Ultra-widefield fundus photograph · 1924x1556 · 200° field of view
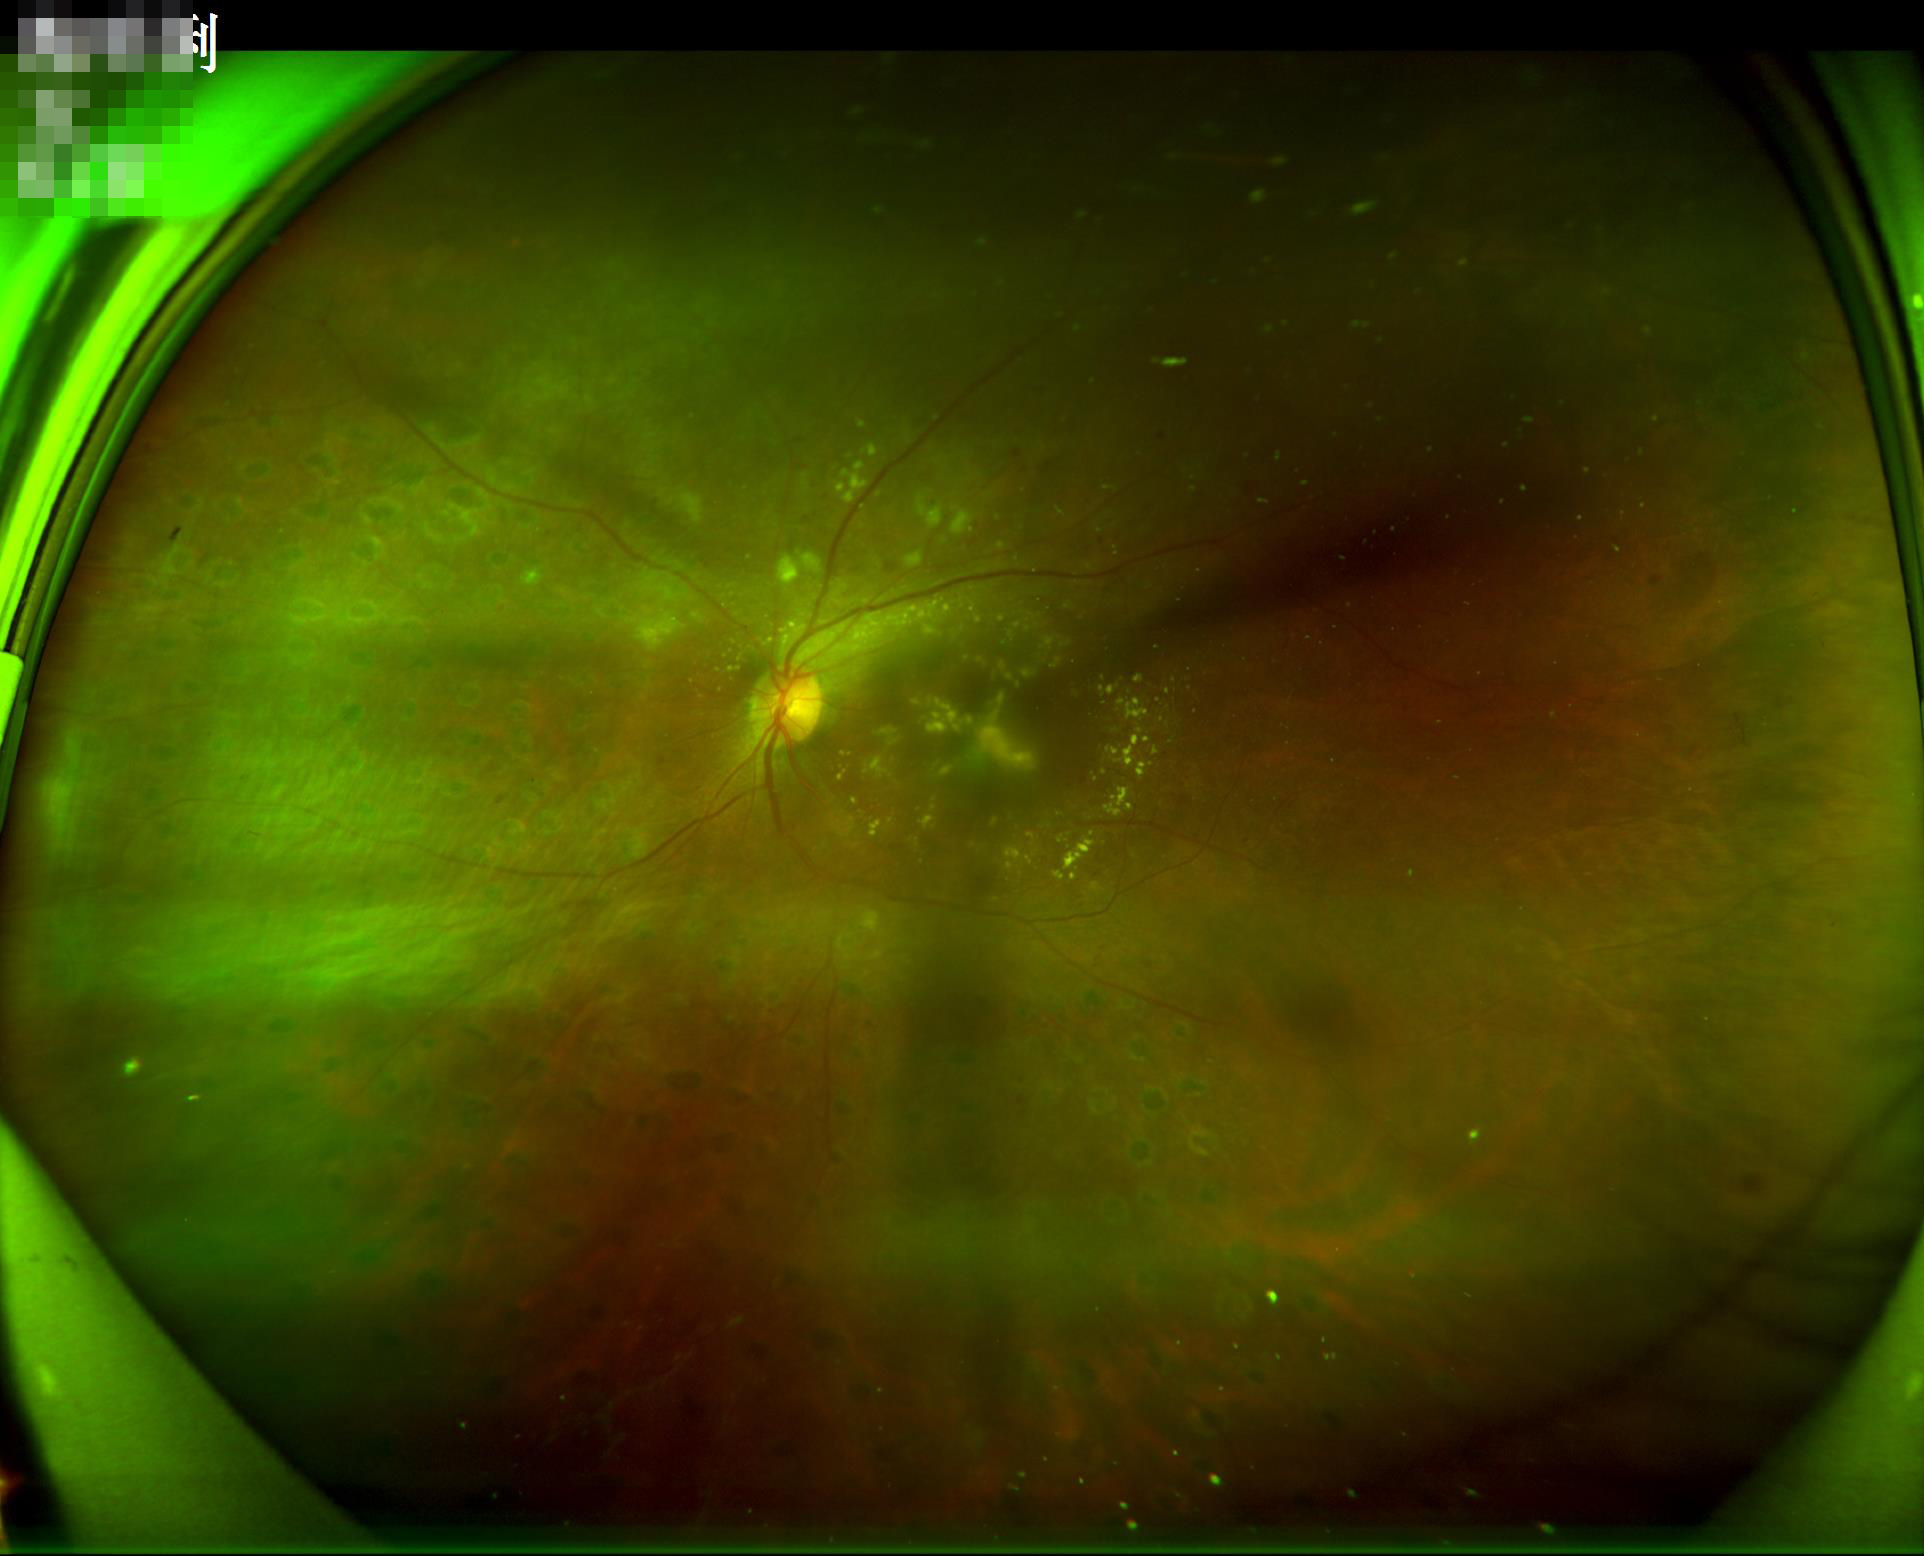 Image quality:
- illumination: inadequate, with uneven exposure or color distortion
- focus: out of focus, structures indistinct
- overall: poor and difficult to use diagnostically
- contrast: good dynamic range